ONH-centered crop from a color fundus image; 35° field of view before cropping: 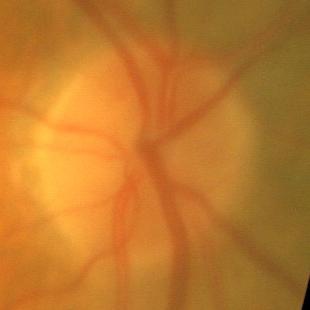 Q: What is the glaucoma diagnosis?
A: No — no glaucomatous damage.